848x848px, without pupil dilation, 45° field of view.
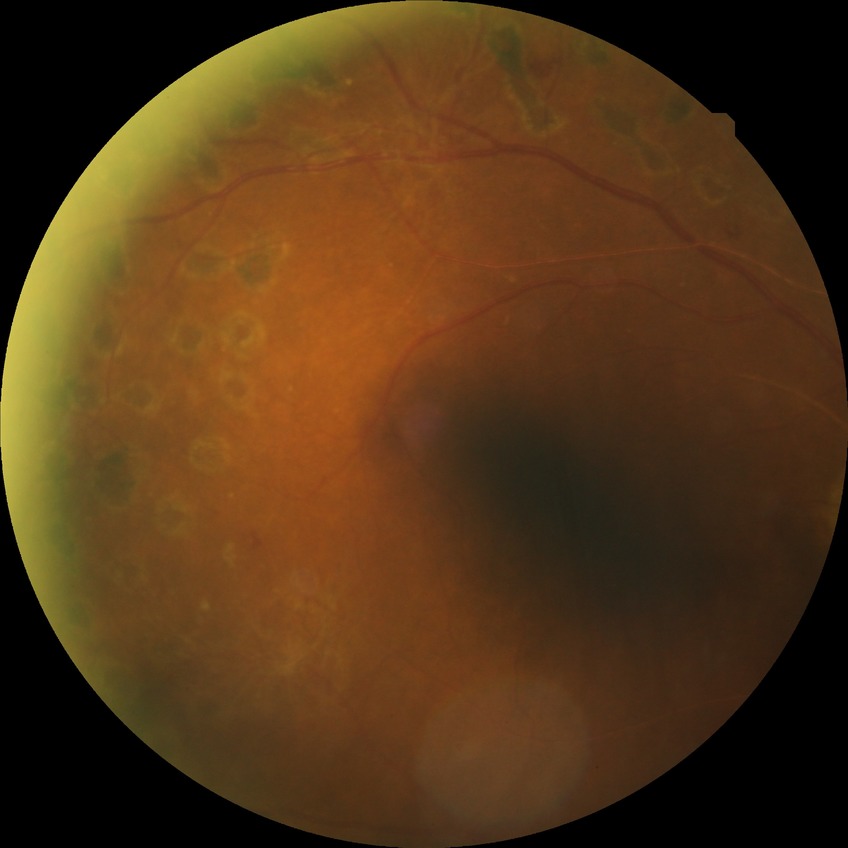
diabetic retinopathy (DR): proliferative diabetic retinopathy (PDR).